45-degree field of view. Nonmydriatic.
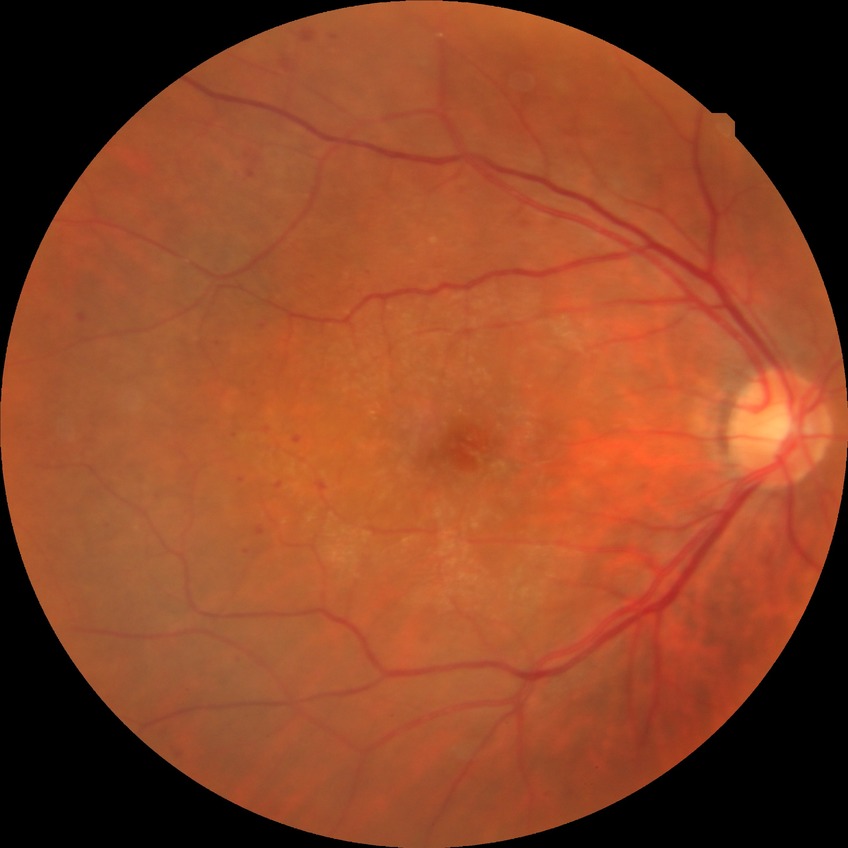 diabetic retinopathy (DR): SDR (simple diabetic retinopathy).